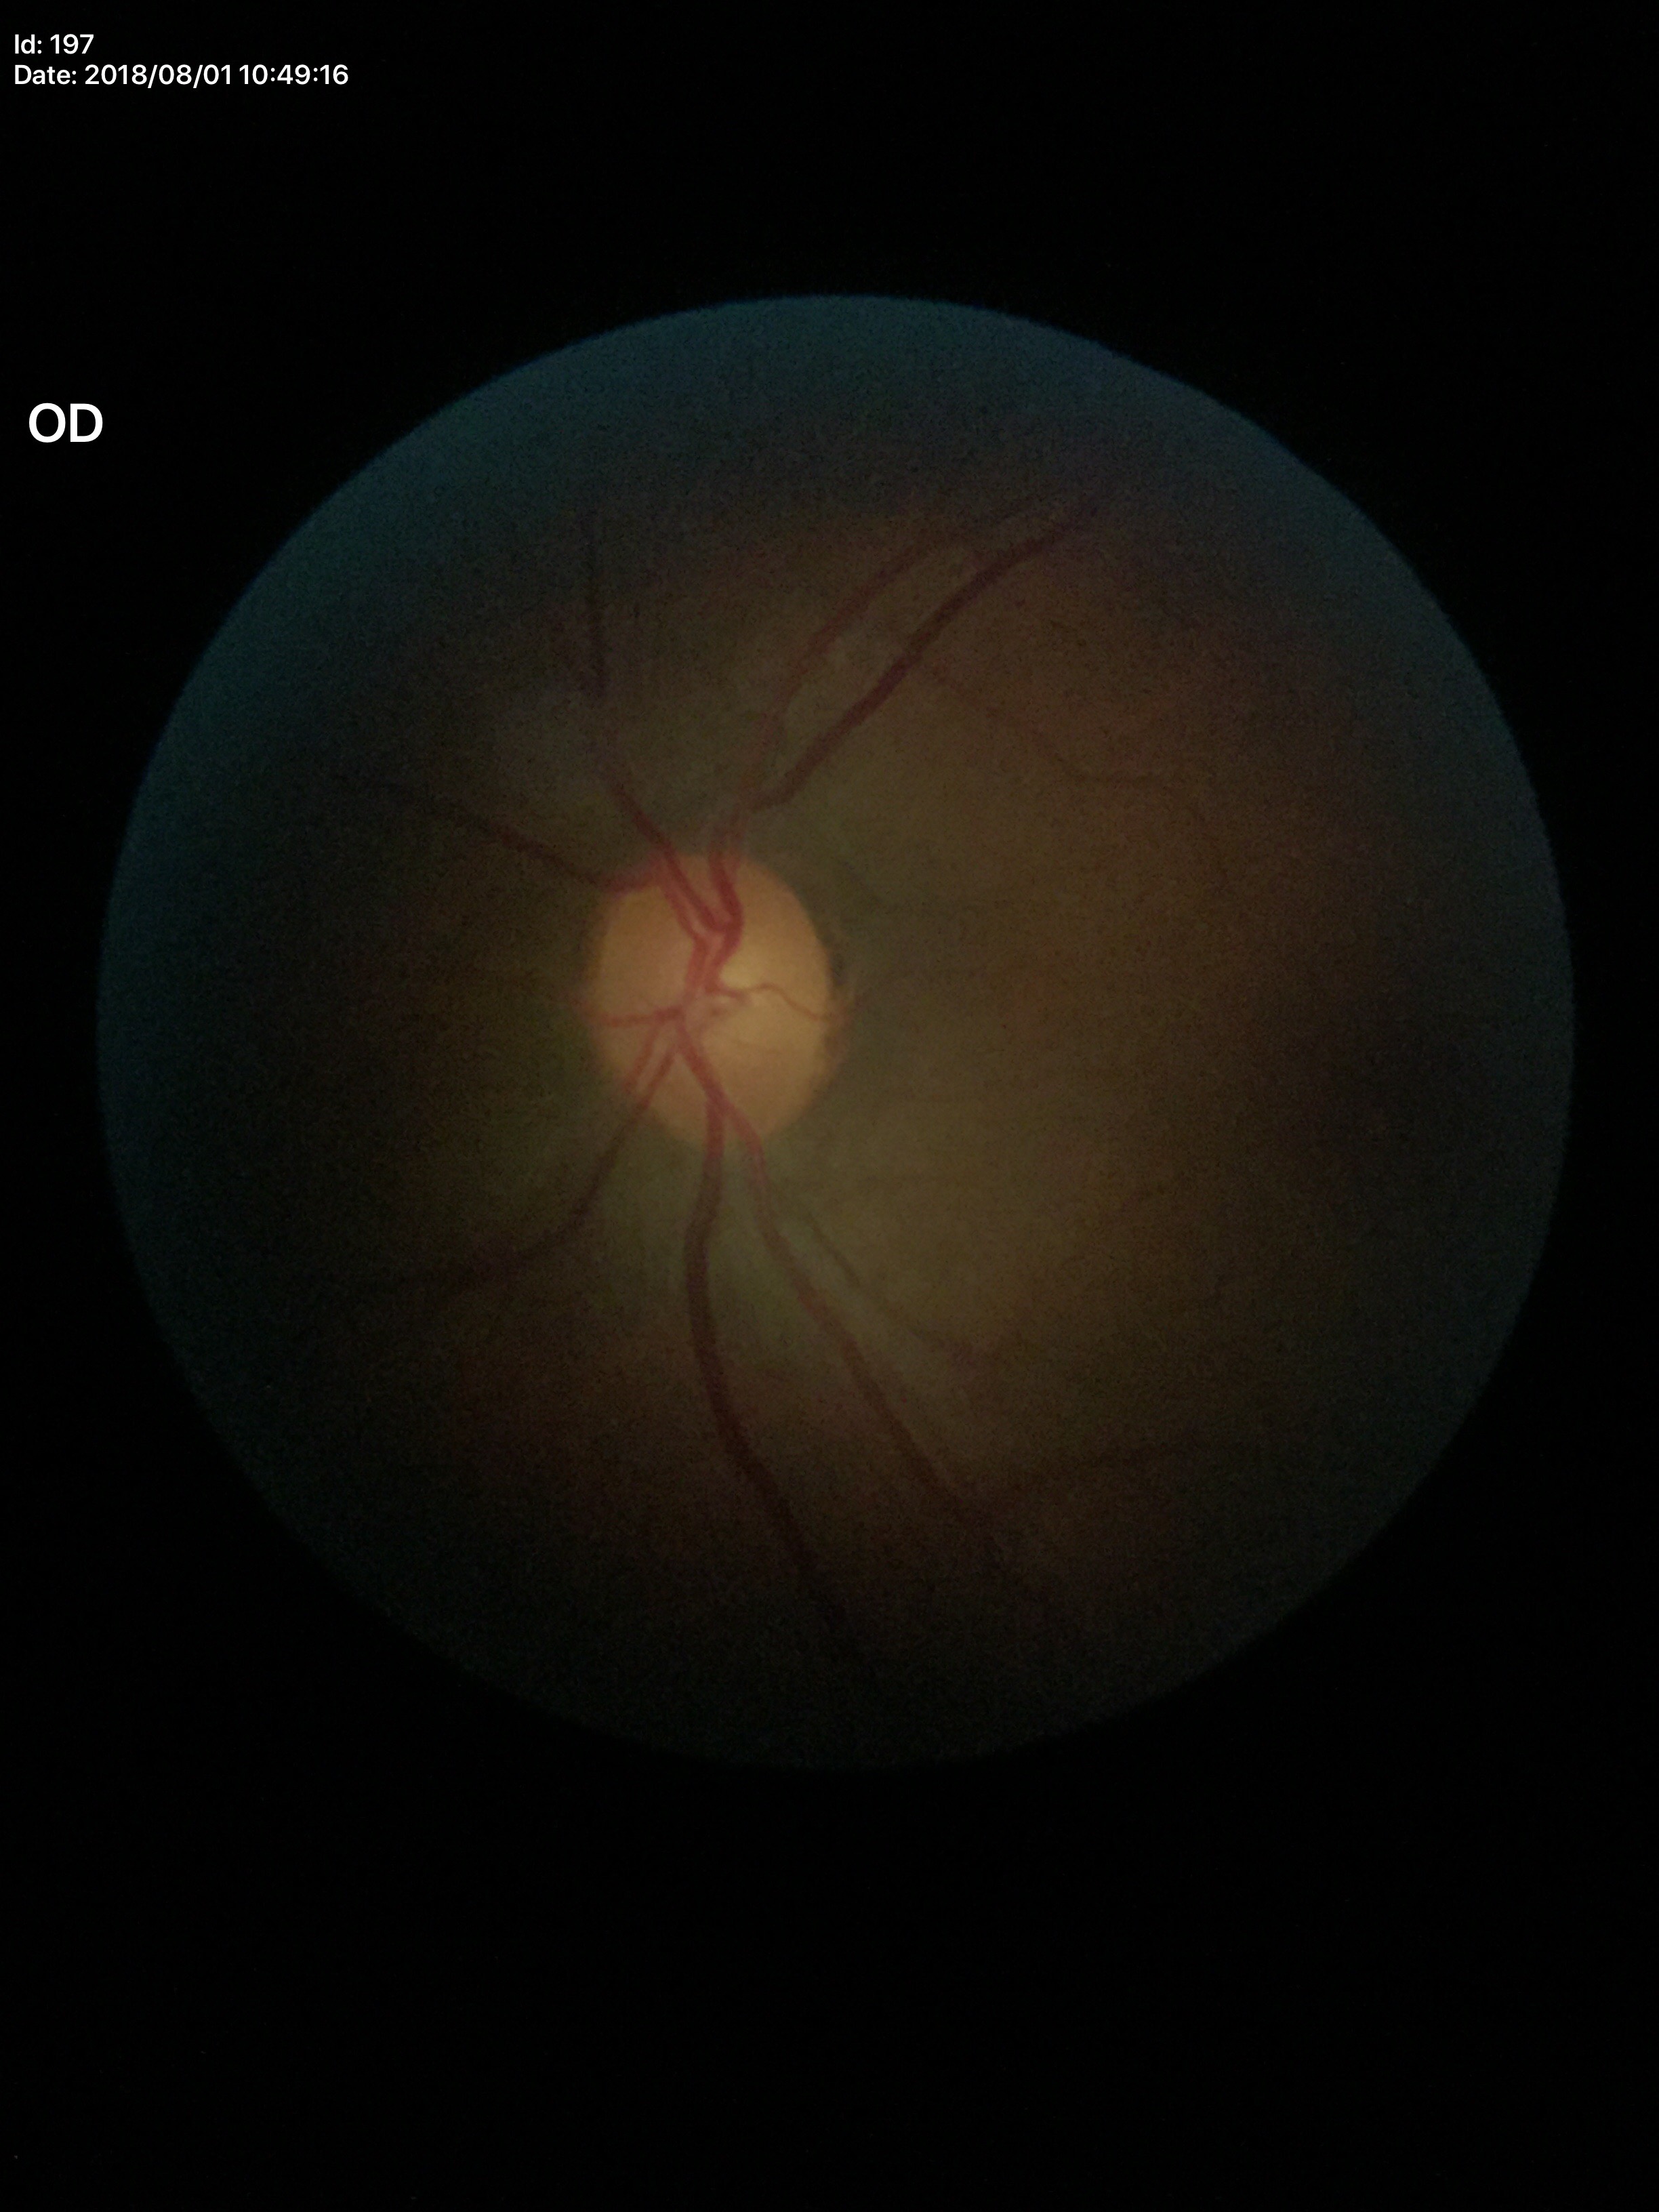 No evidence of glaucoma. Vertical cup-to-disc ratio (VCDR) is 0.44.